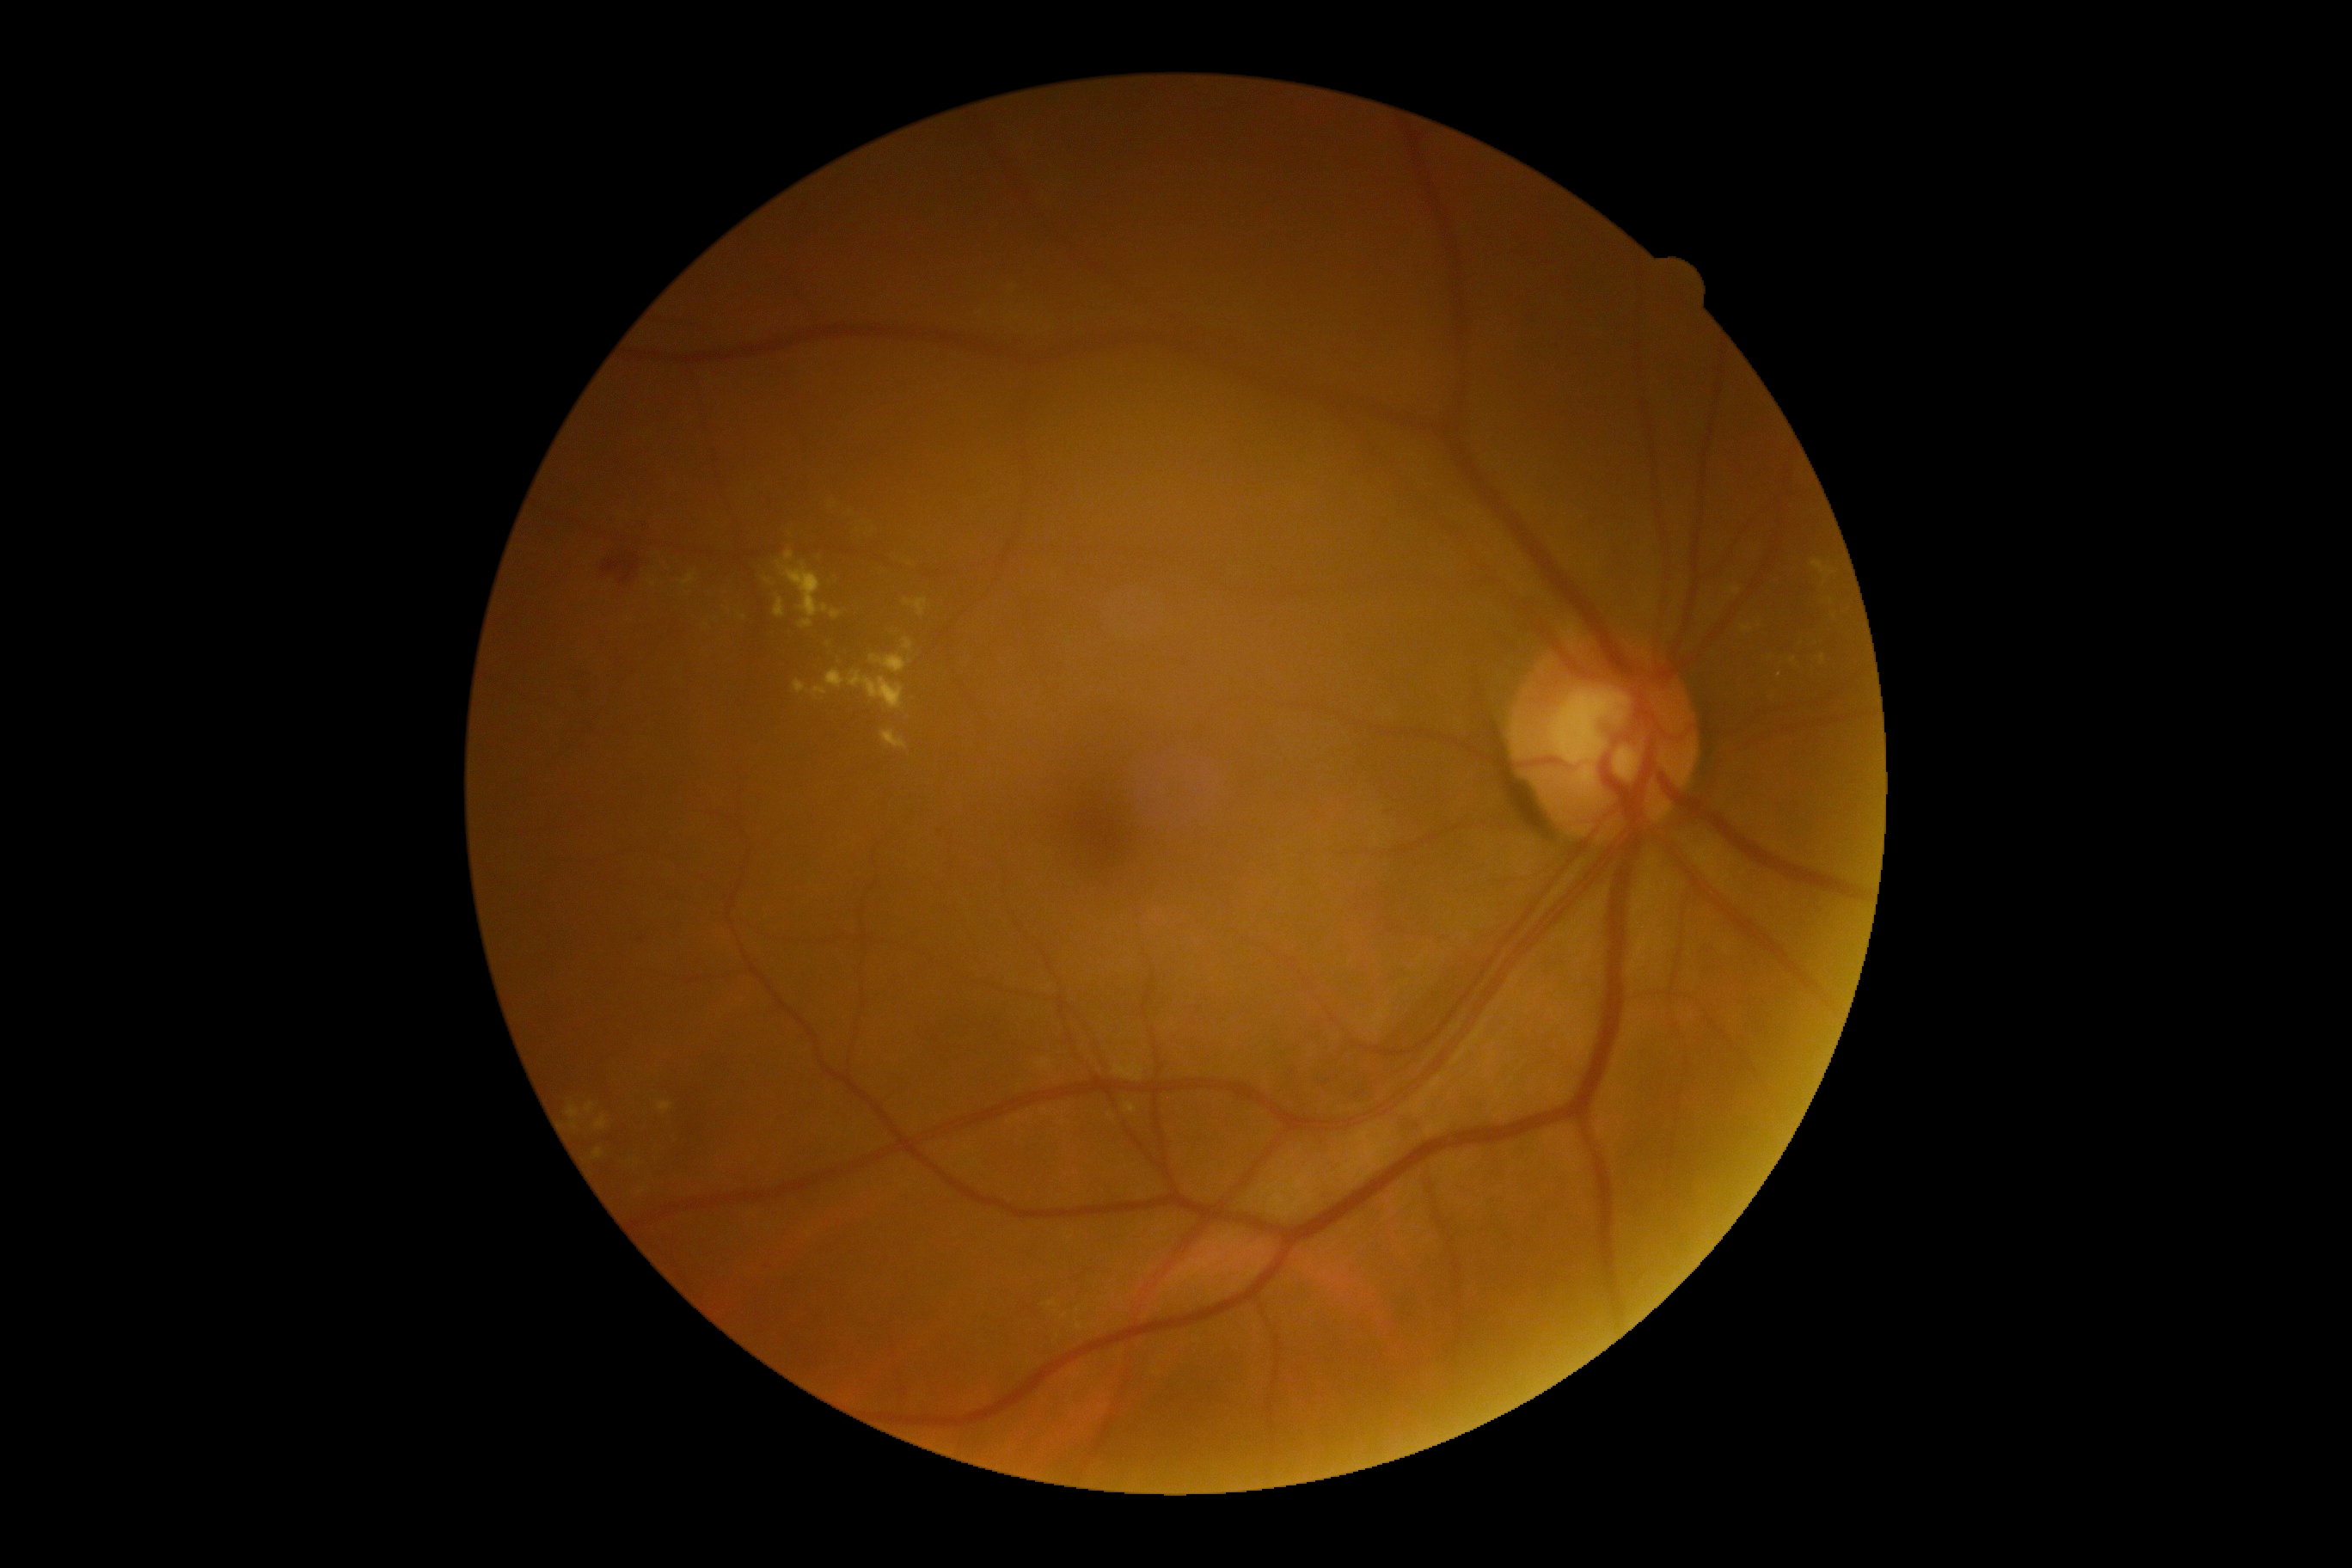
Diabetic retinopathy (DR) is 2; non-proliferative diabetic retinopathy
Representative lesions:
soft exudates (SEs): absent
hemorrhages (HEs): x1=603, y1=560, x2=639, y2=585
hard exudates (EXs) (subset): x1=903, y1=639, x2=914, y2=652; x1=1813, y1=560, x2=1832, y2=575; x1=903, y1=599, x2=928, y2=618; x1=830, y1=609, x2=842, y2=618; x1=594, y1=1149, x2=604, y2=1158; x1=682, y1=573, x2=695, y2=587; x1=649, y1=580, x2=659, y2=587; x1=824, y1=642, x2=838, y2=654; x1=776, y1=561, x2=828, y2=628; x1=659, y1=1103, x2=671, y2=1115; x1=793, y1=680, x2=805, y2=695; x1=785, y1=551, x2=795, y2=561; x1=1822, y1=654, x2=1827, y2=666; x1=826, y1=670, x2=845, y2=689; x1=871, y1=656, x2=907, y2=675
EXs (small, approximate centers) near [x=1078, y=1311]; [x=1065, y=1316]; [x=744, y=618]
MAs (small, approximate centers) near [x=647, y=521]